Wide-field retinal mosaic image · image size 1924x1556
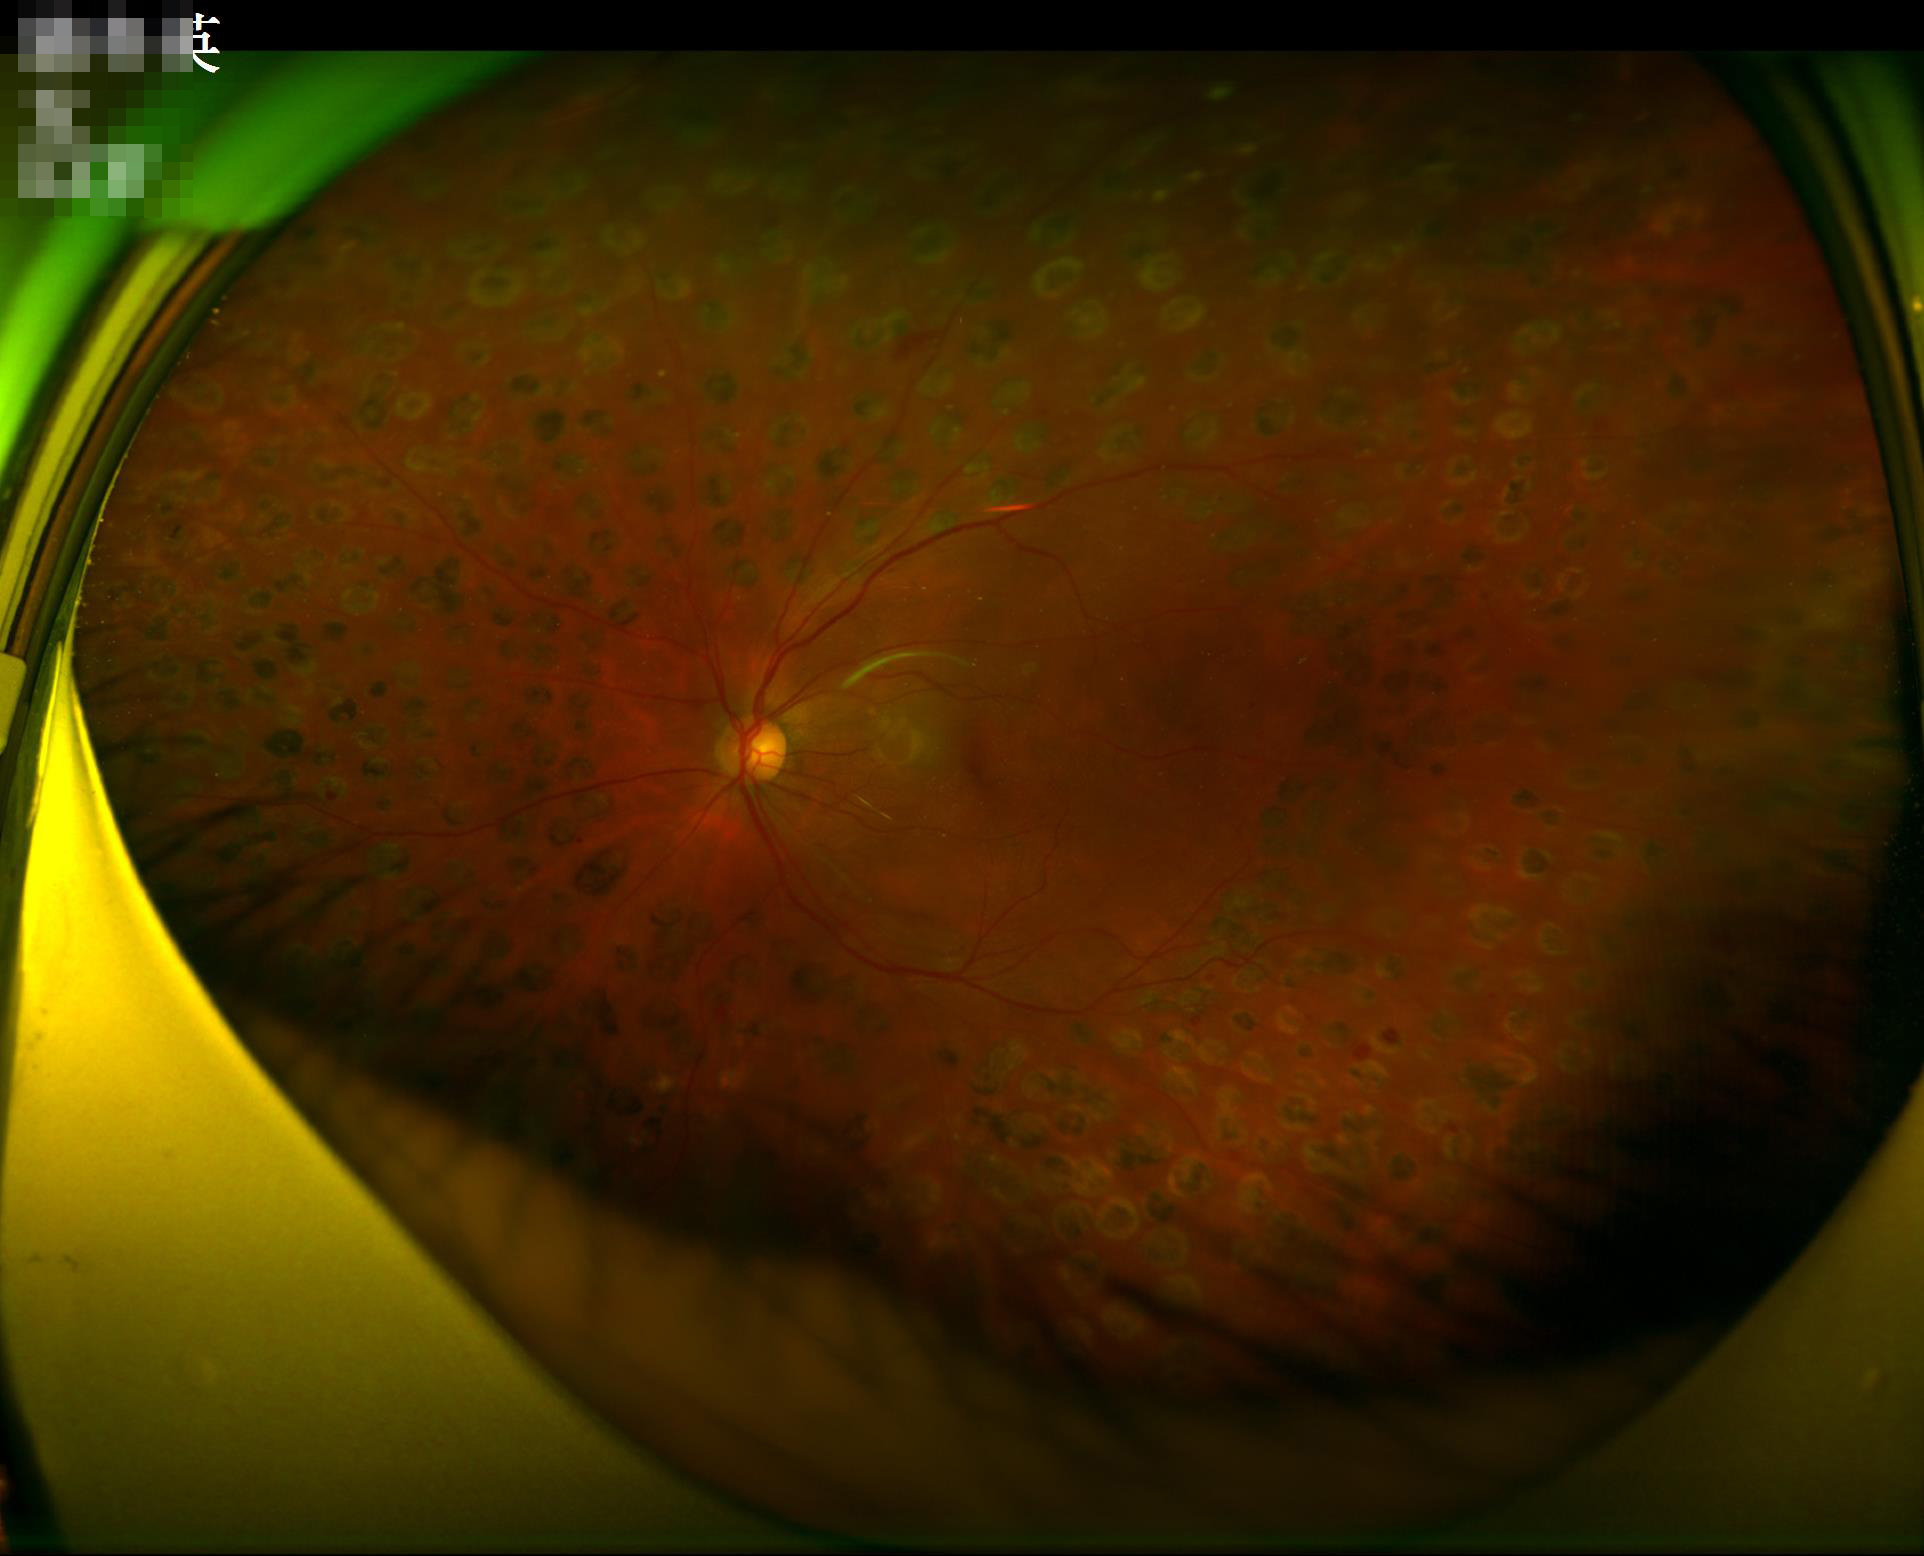 {"illumination": "uneven", "clarity": "sharp", "overall_quality": "satisfactory"}